FOV: 45 degrees, retinal fundus photograph, 2352 x 1568 pixels:
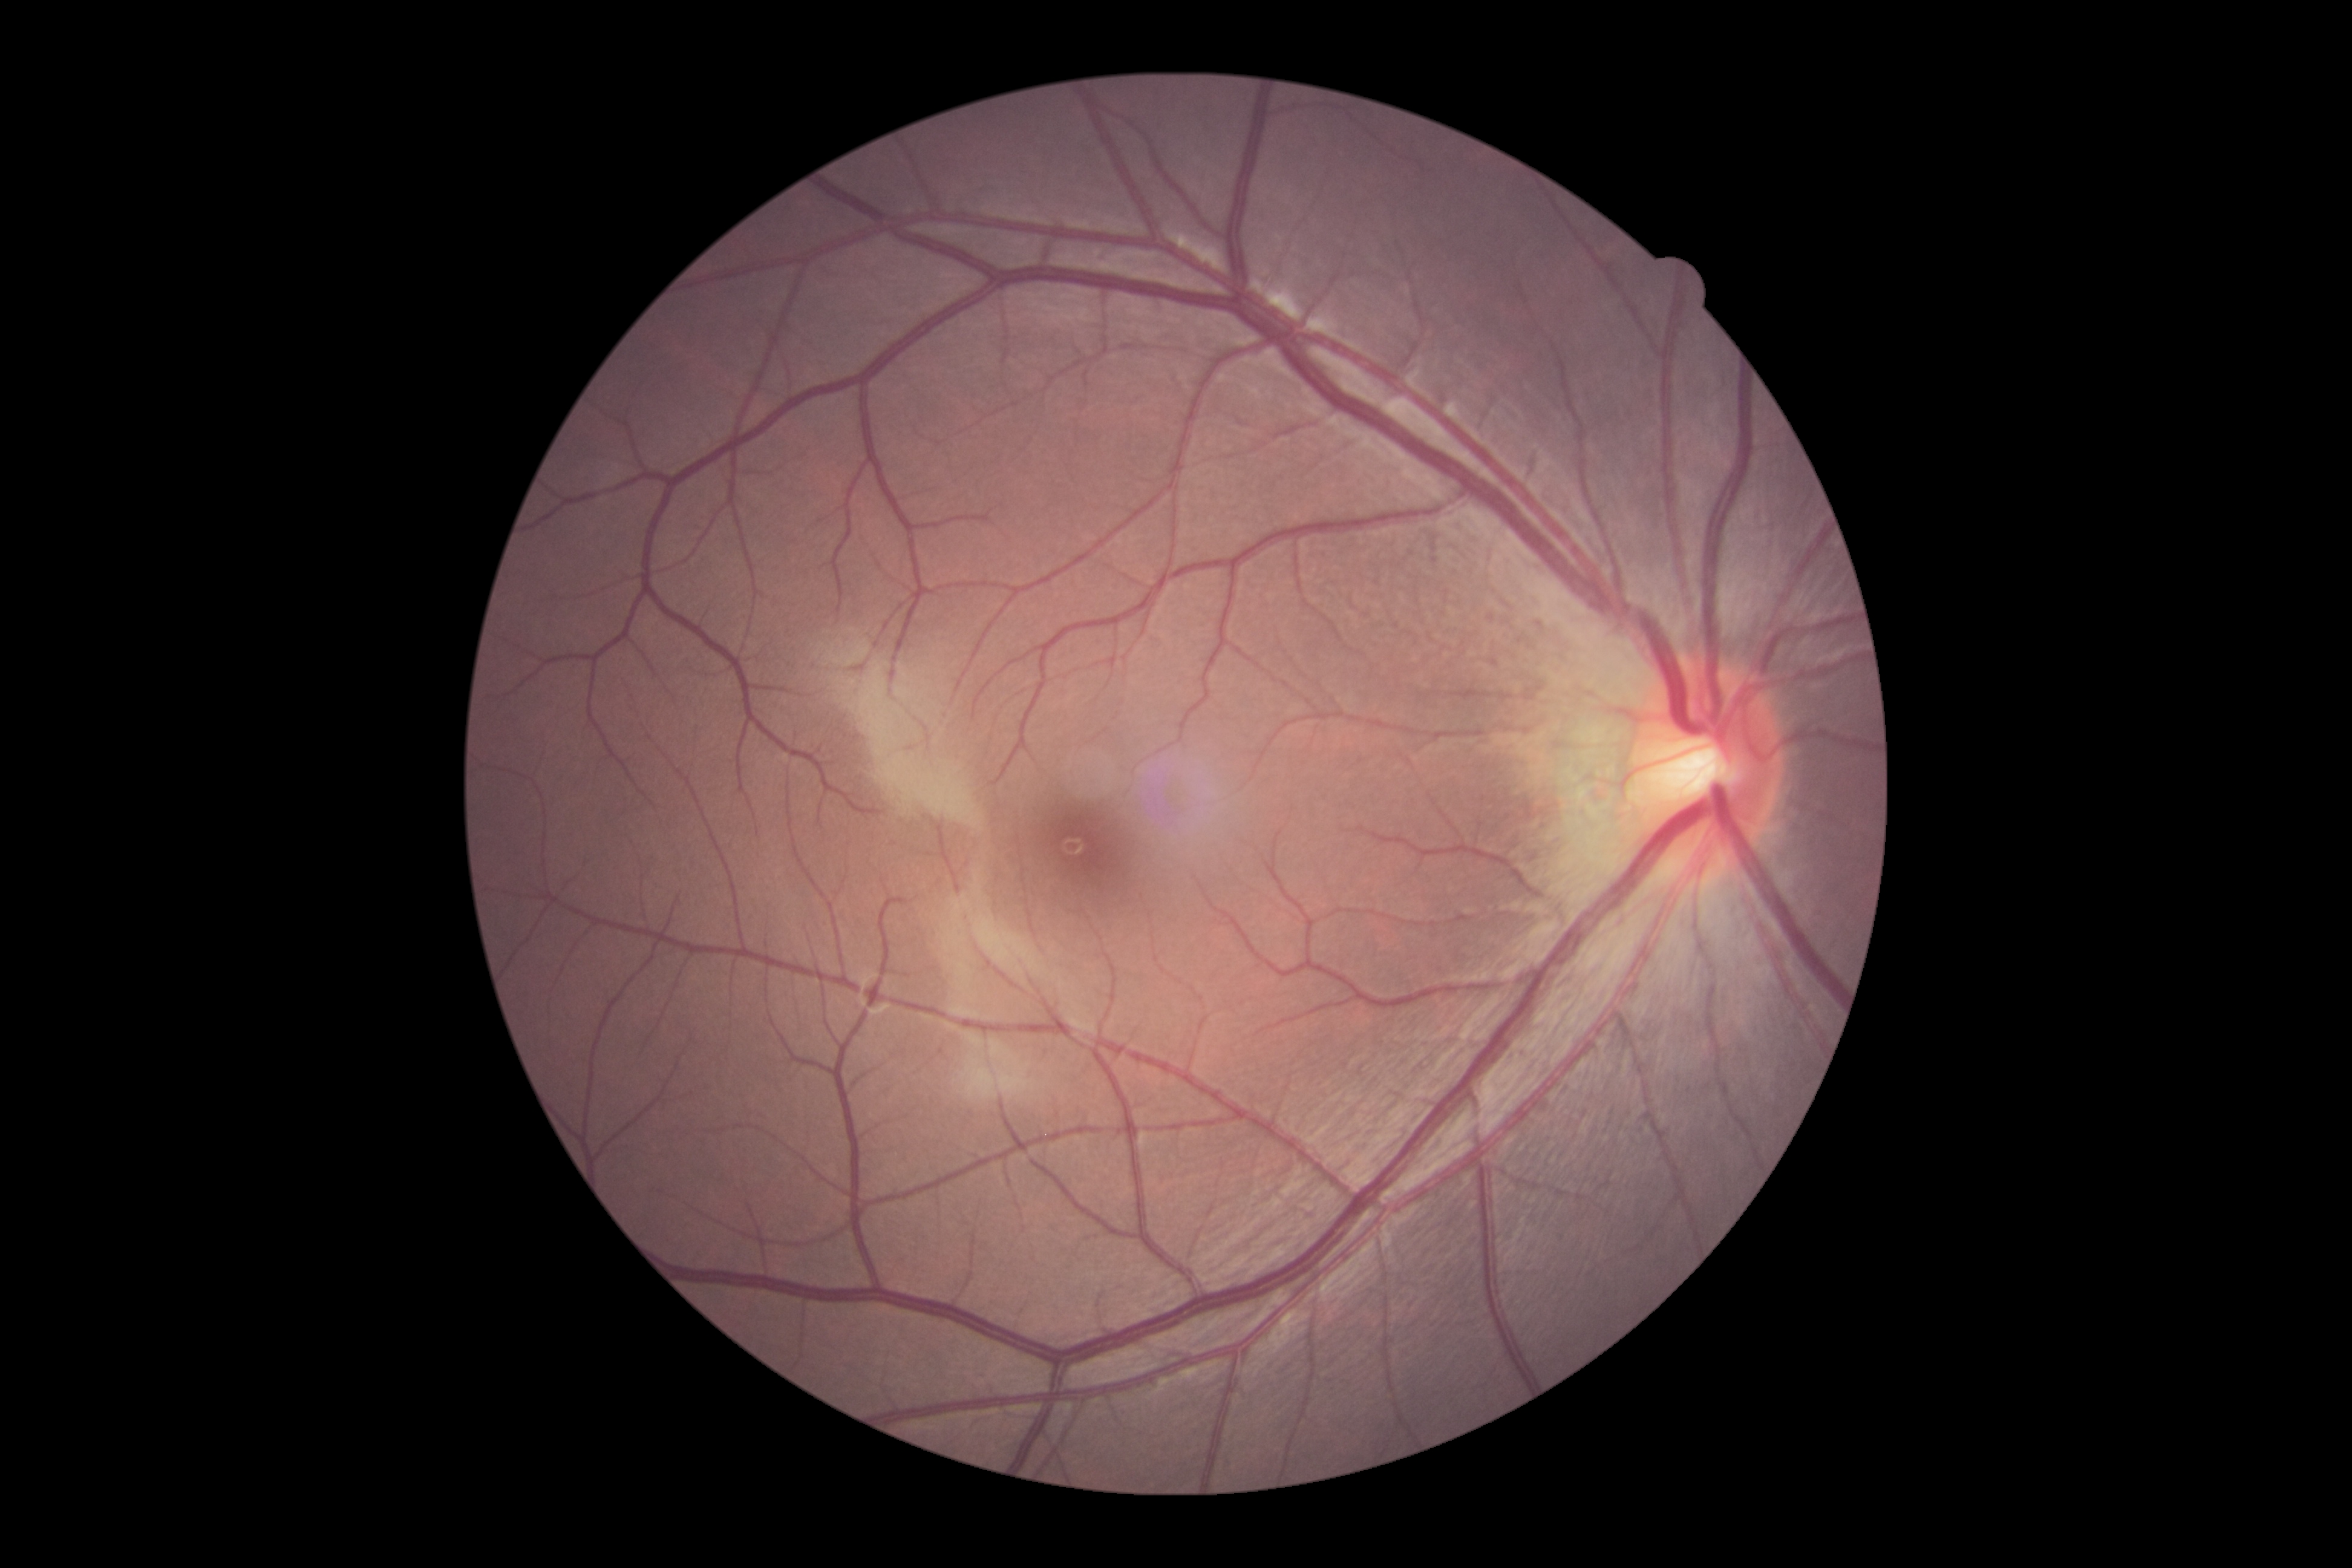
Findings:
• DR grade: no apparent retinopathy (0) — no visible signs of diabetic retinopathy